2048x1536 — 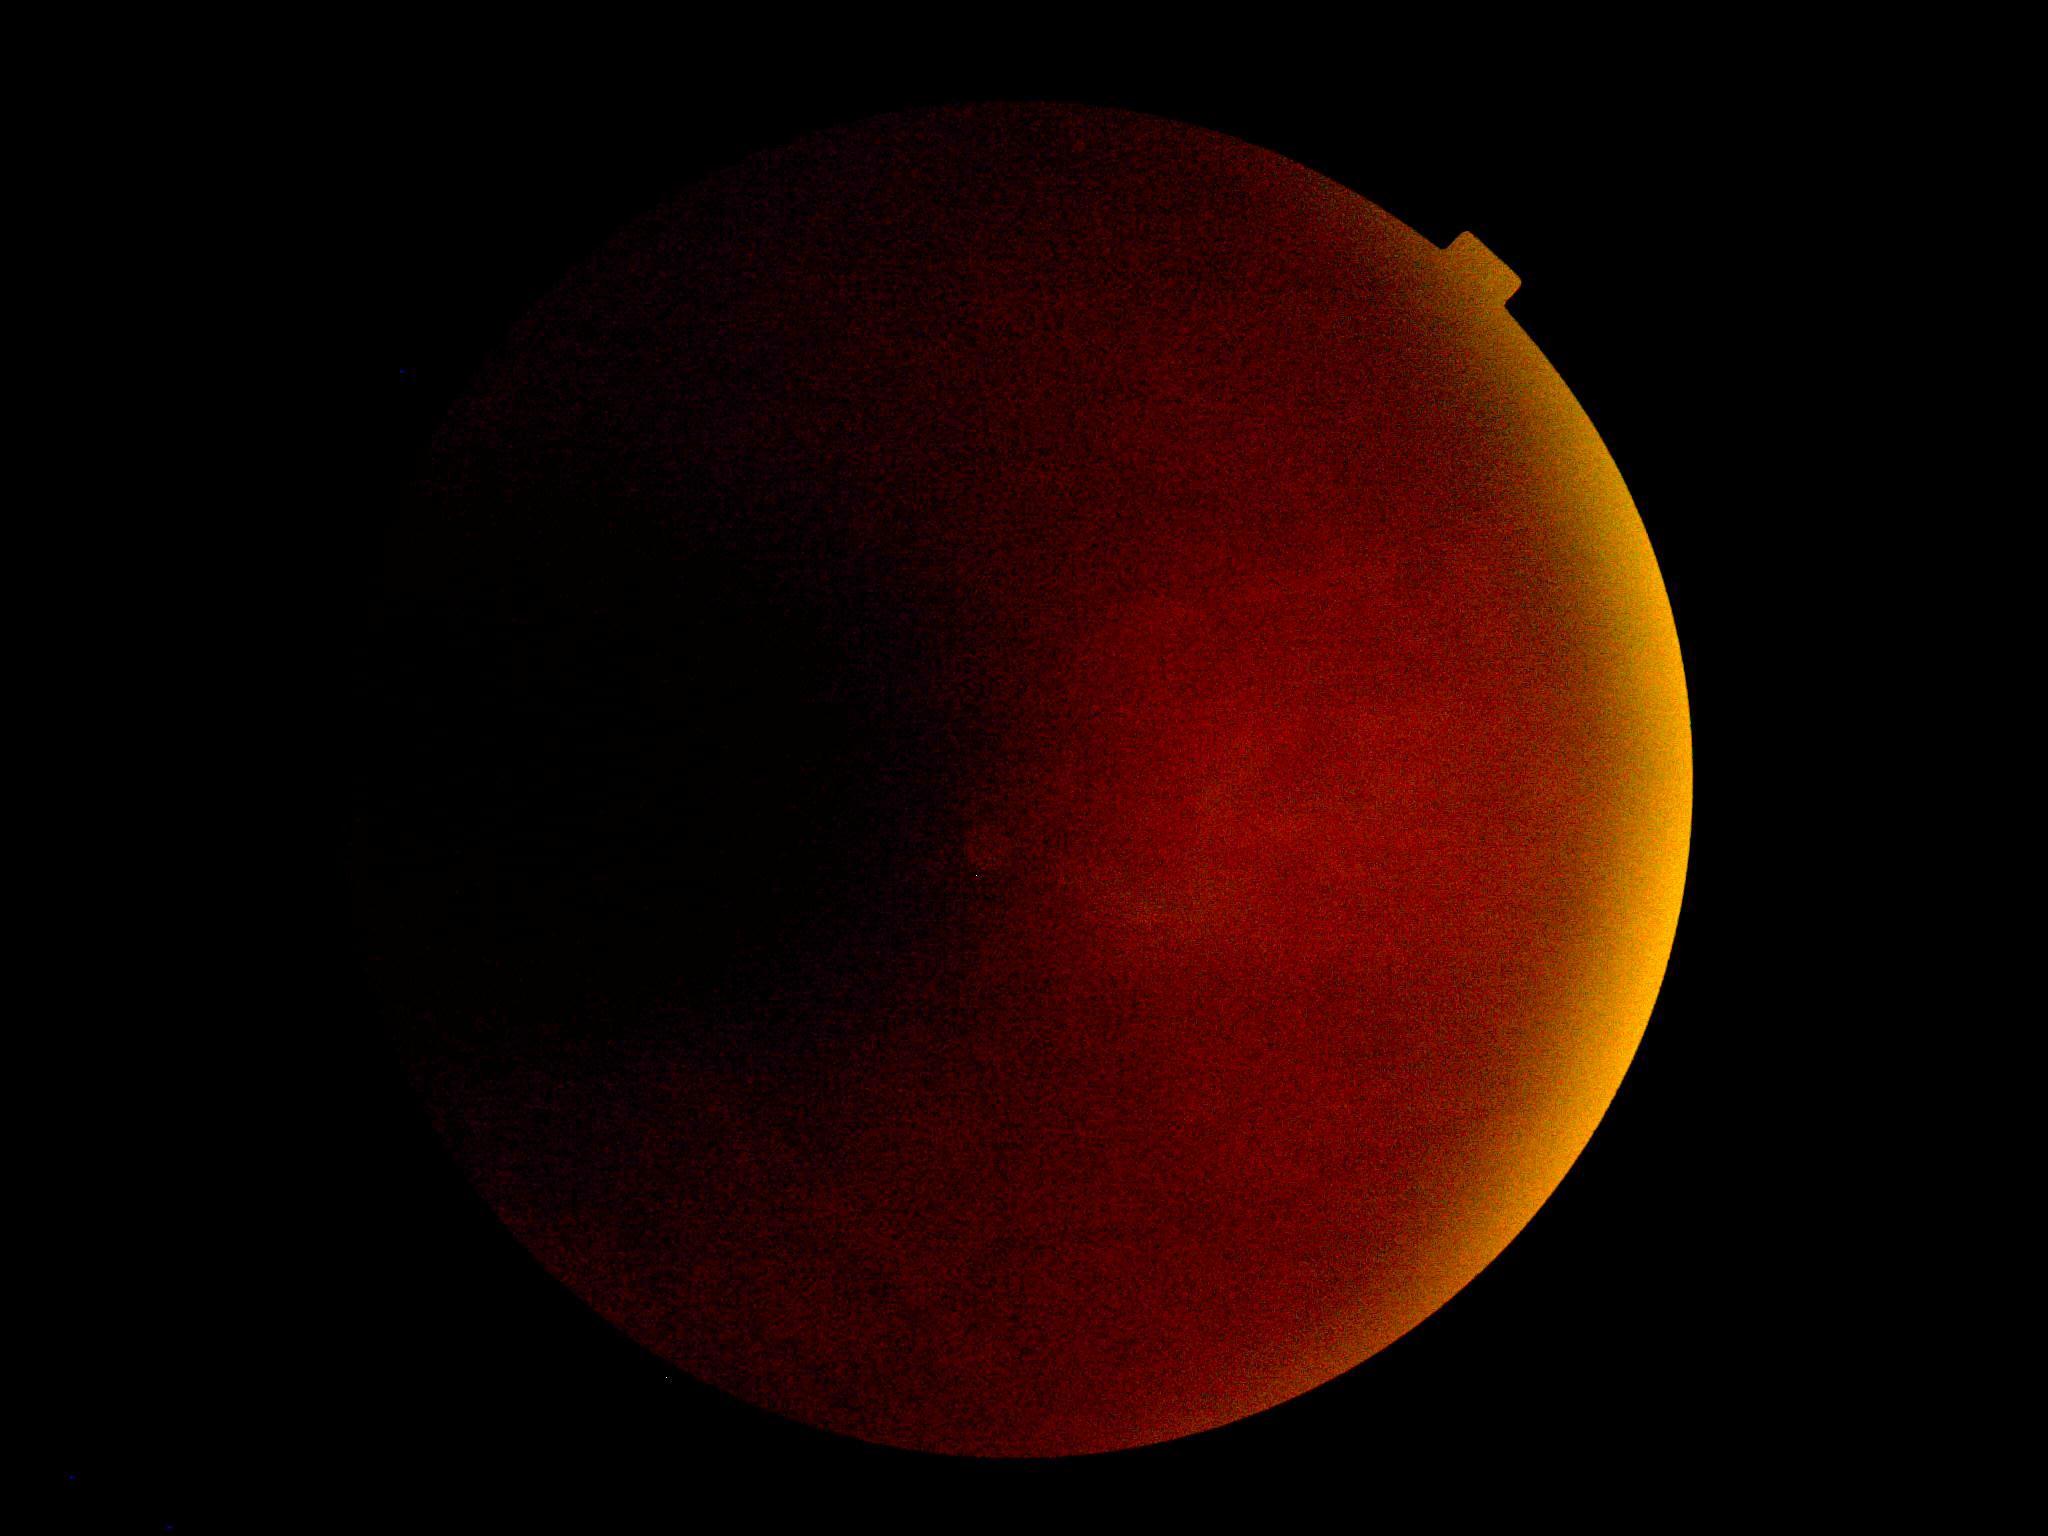

• image quality: insufficient for DR assessment
• diabetic retinopathy severity: ungradable